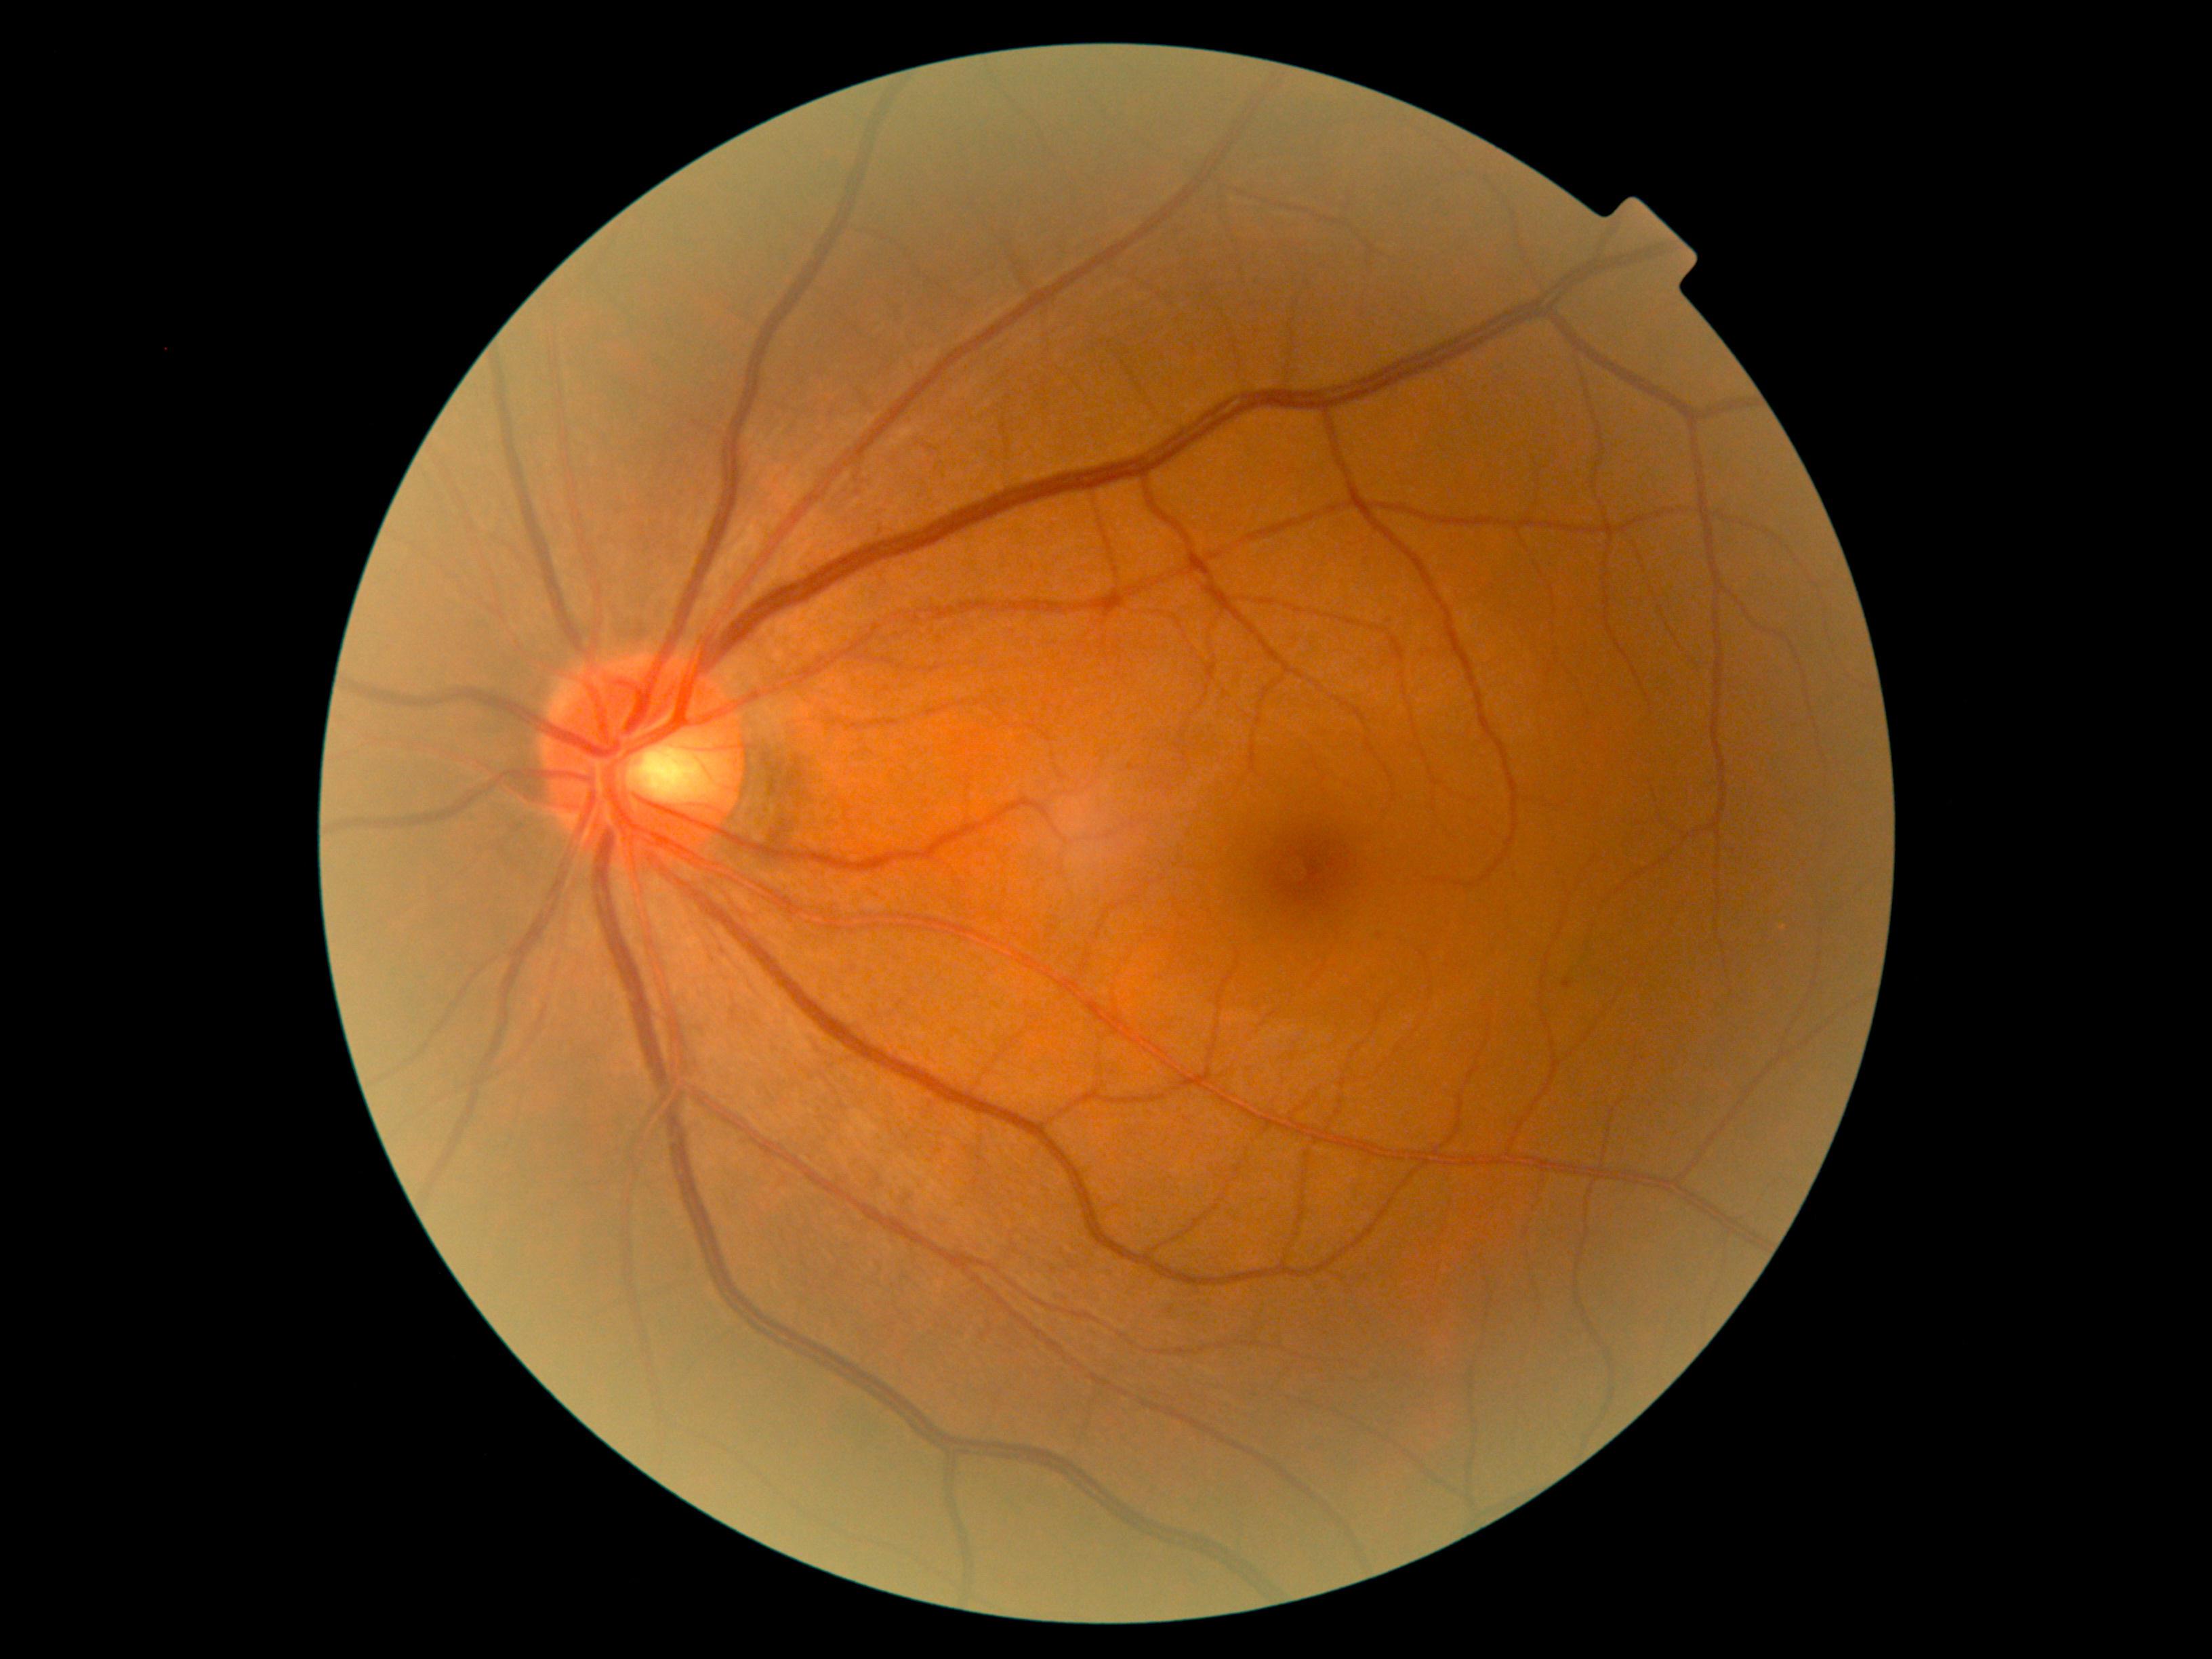

DR grade: 1 (mild NPDR).